848x848px, acquired with a NIDEK AFC-230 — 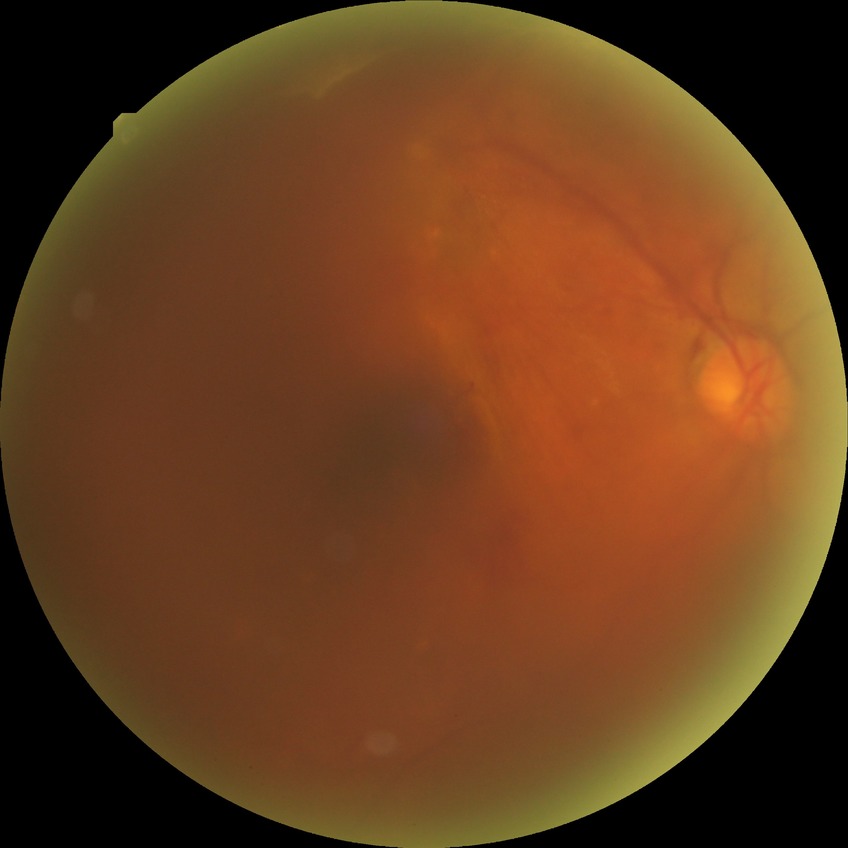
Diabetic retinopathy (DR): PDR (proliferative diabetic retinopathy).